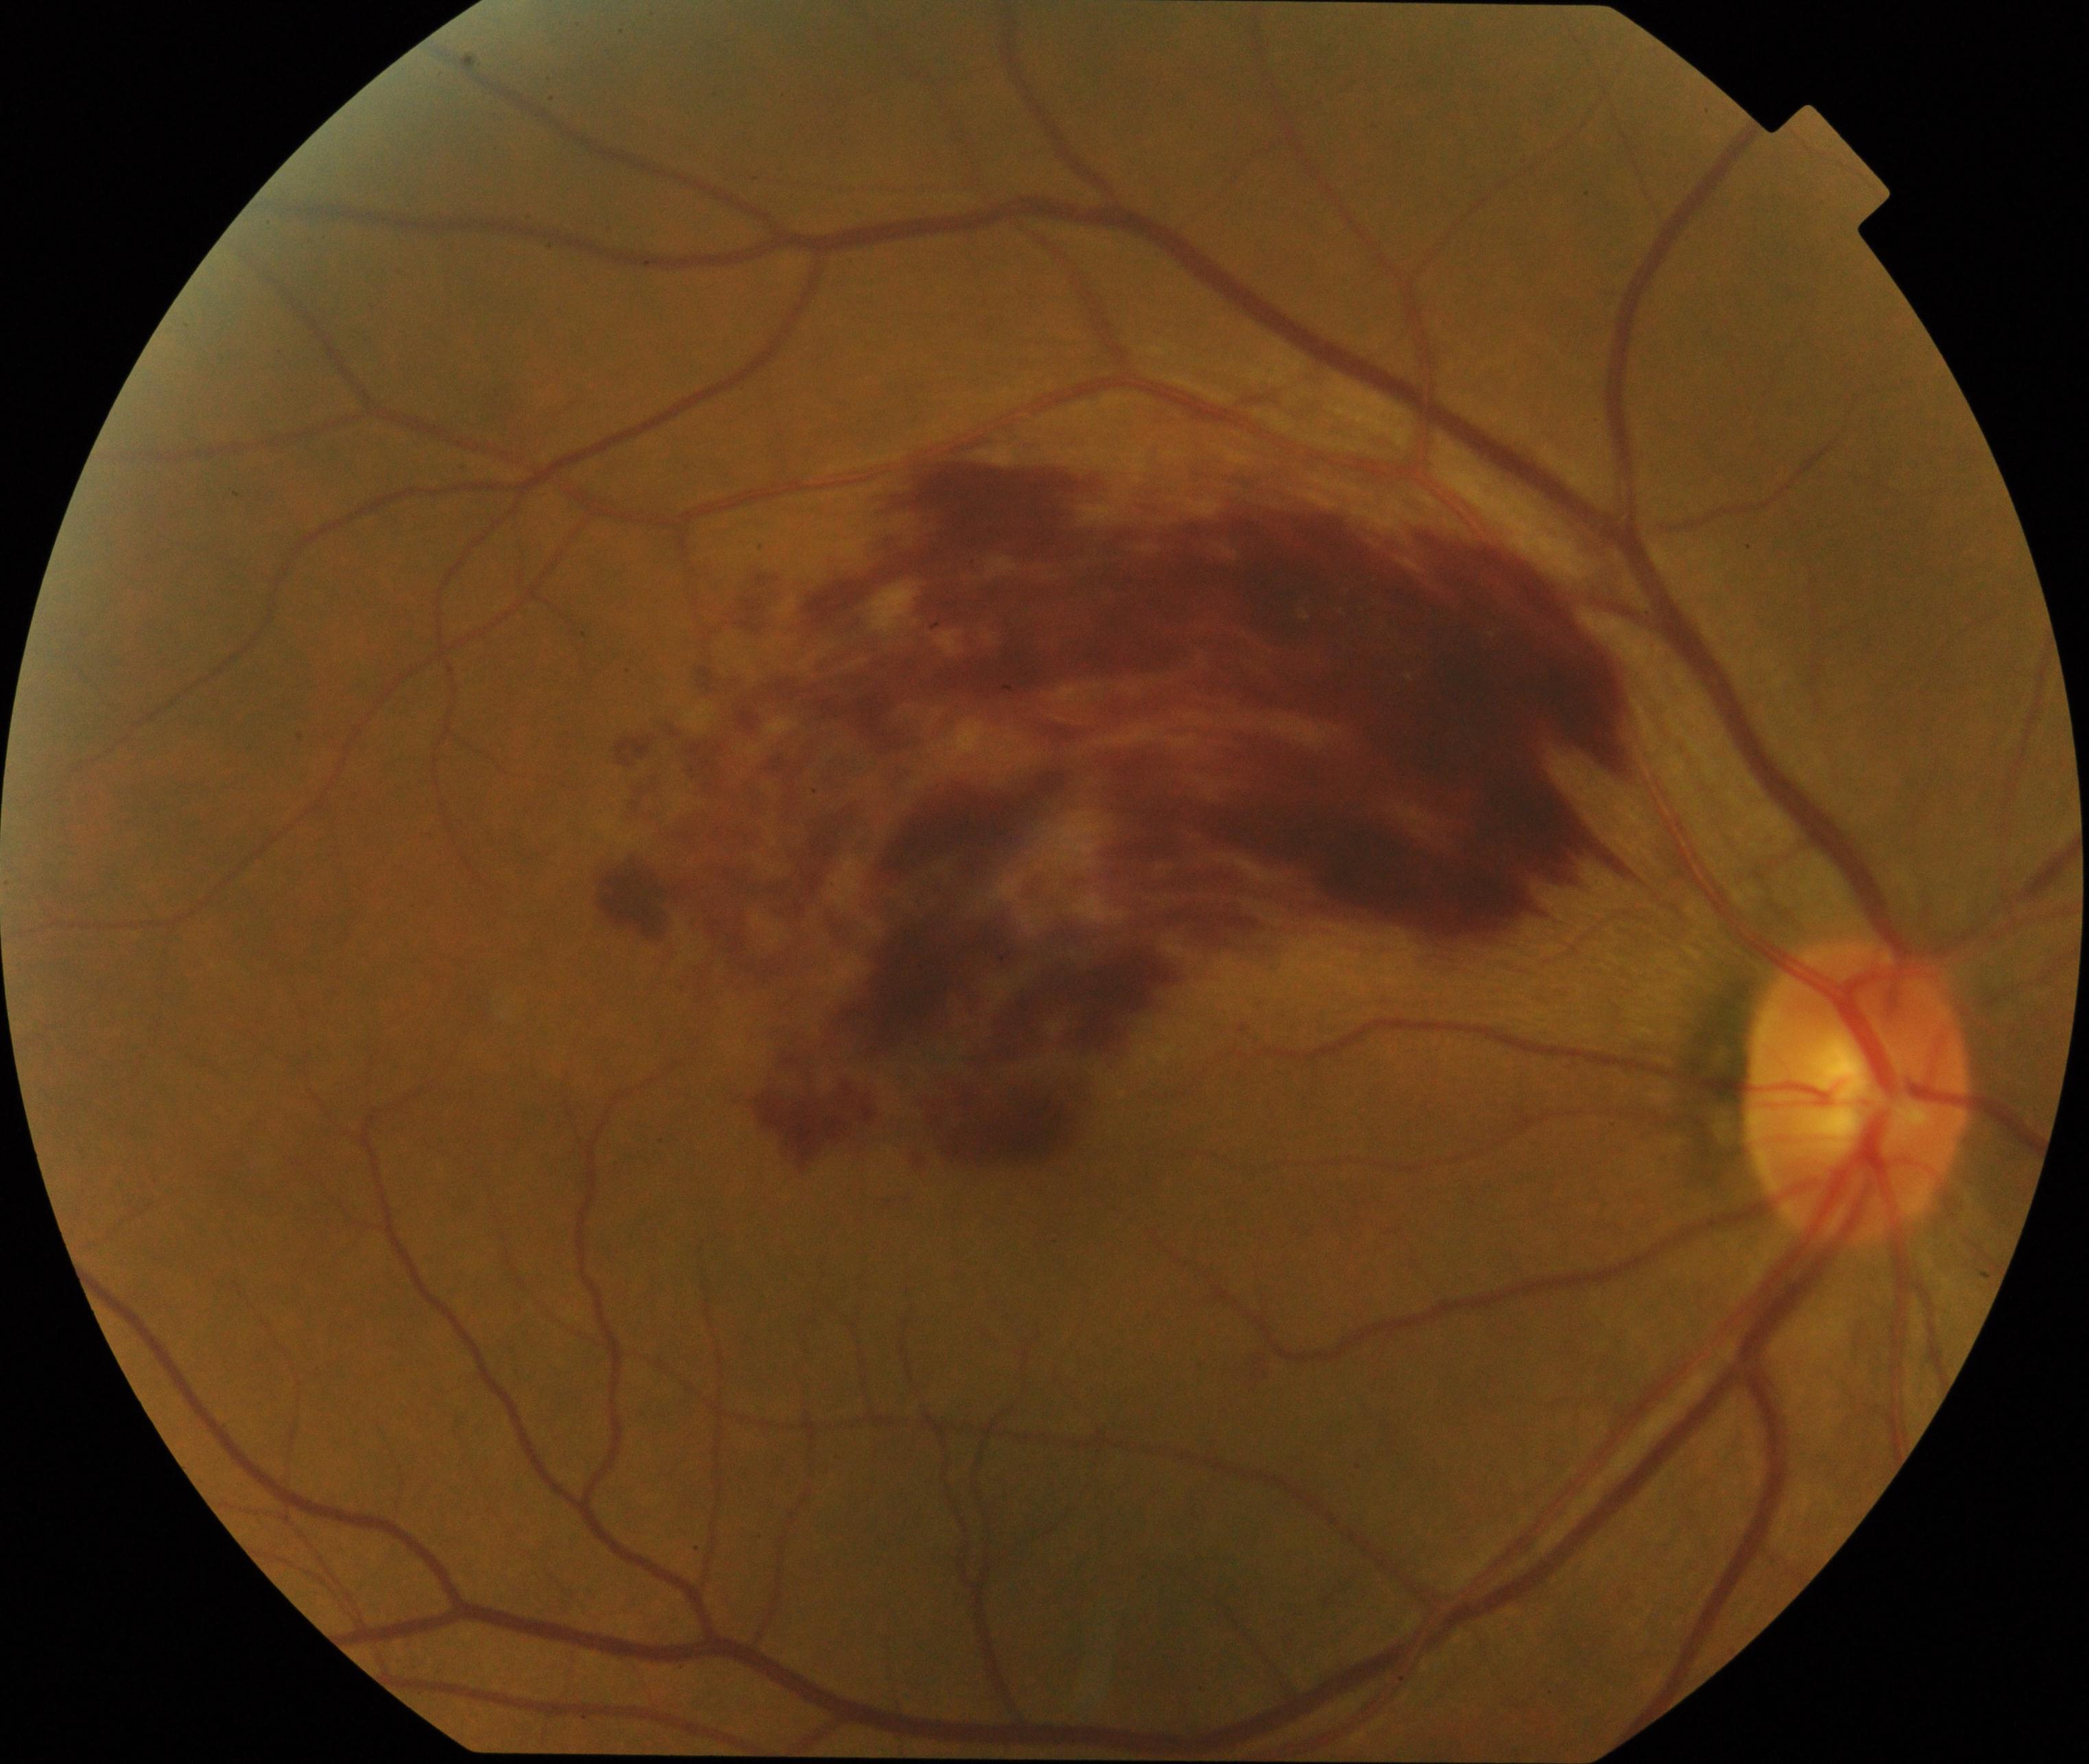

Impression: branch retinal vein occlusion (BRVO). Characterized by tortuosity and dilatation of affected veins, with dot, blot, and flame hemorrhages, sometimes with cotton-wool spots or hard exudates.